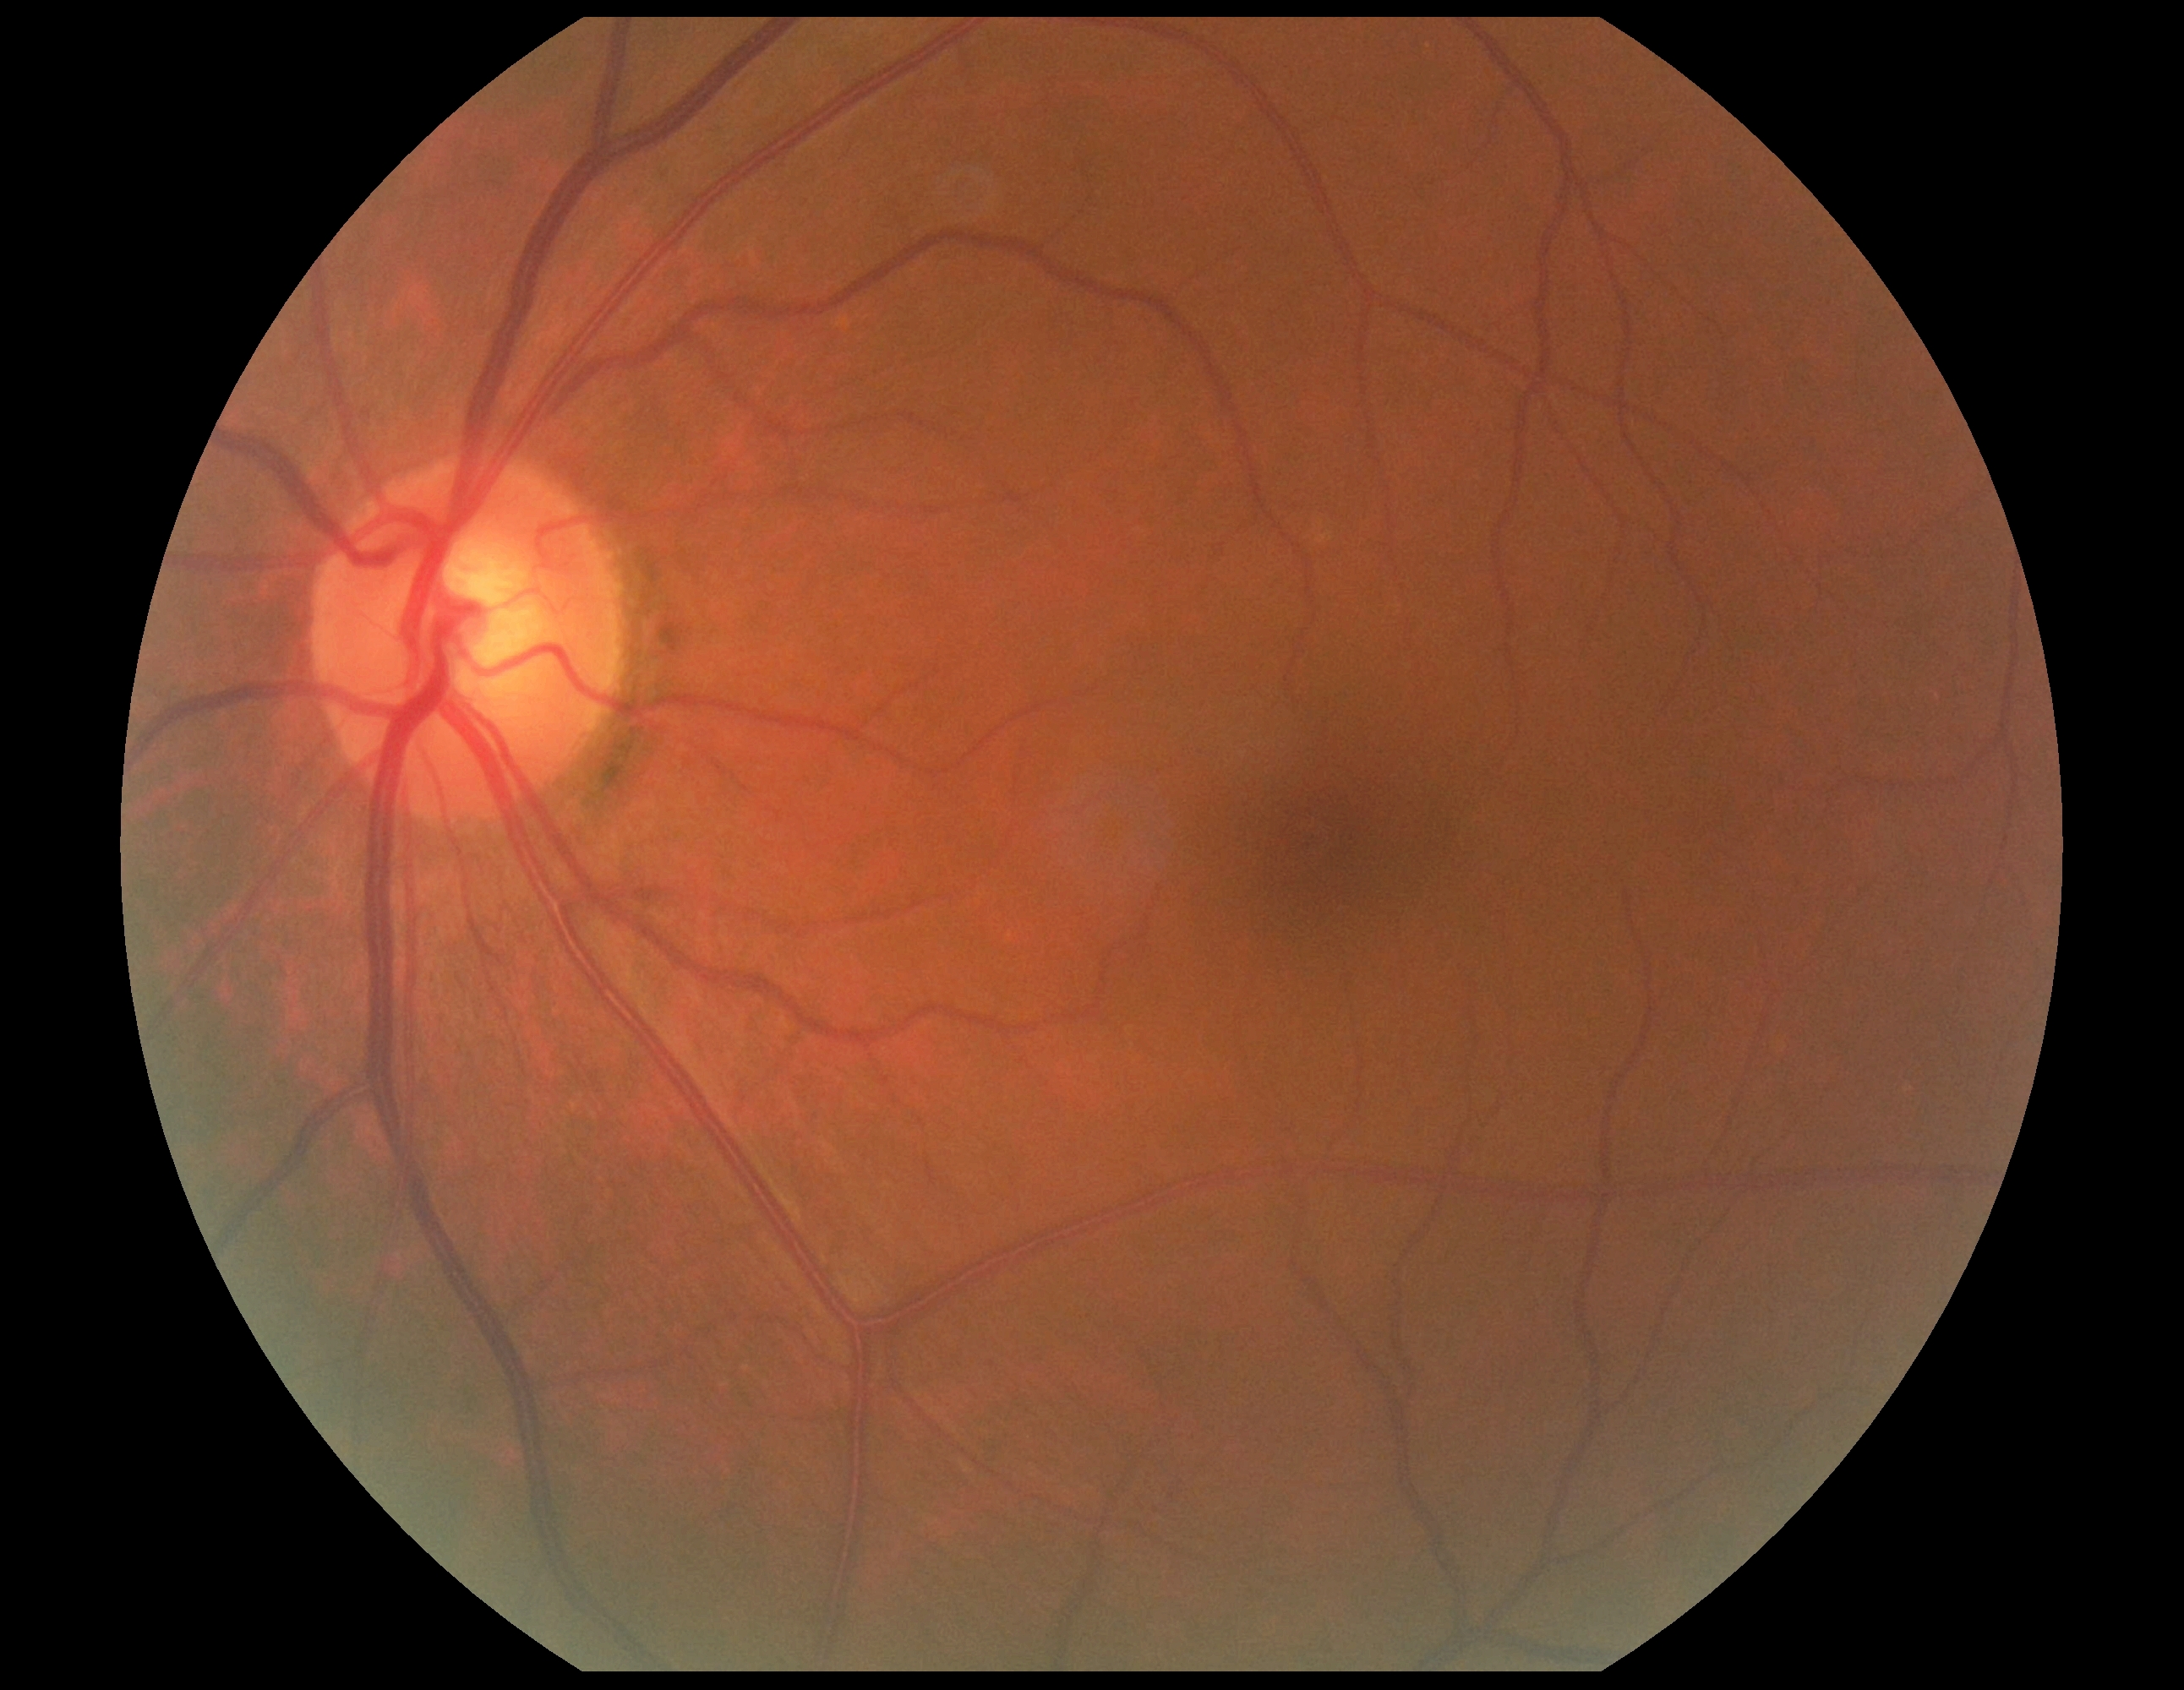

{
  "dr_grade": "0"
}